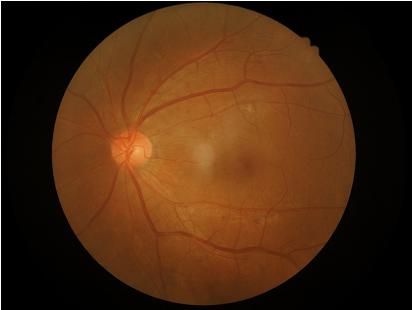
Acceptable image quality. Adequate contrast for distinguishing structures. No over- or under-exposure. No noticeable blur.